Modified Davis grading — 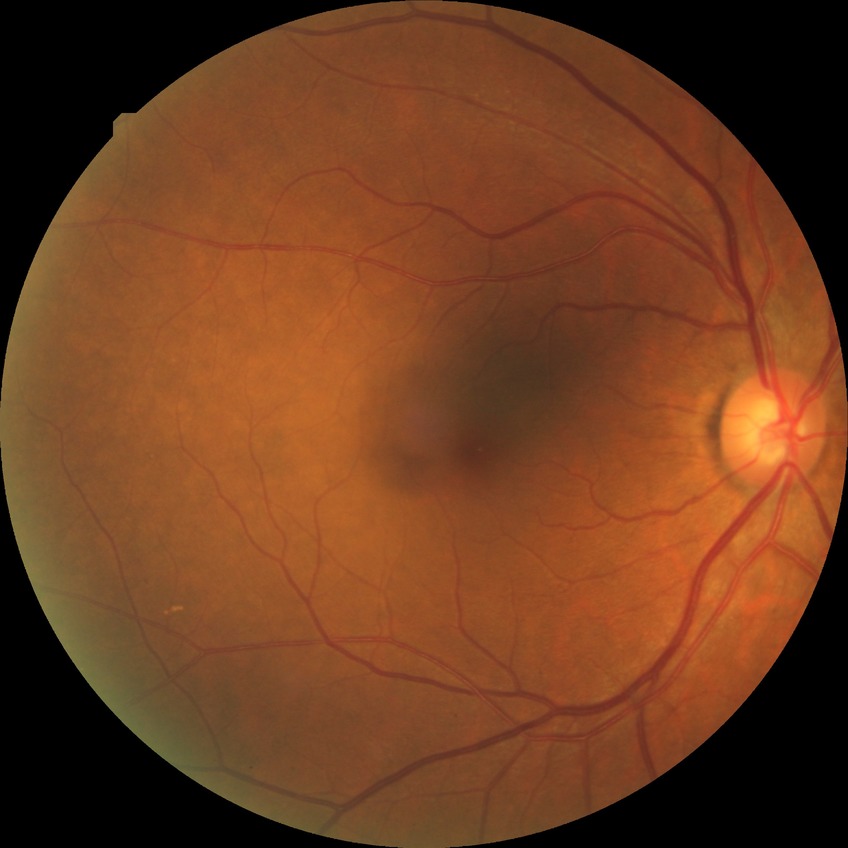

Diabetic retinopathy (DR) is no diabetic retinopathy (NDR).